Wide-field fundus photograph from neonatal ROP screening: 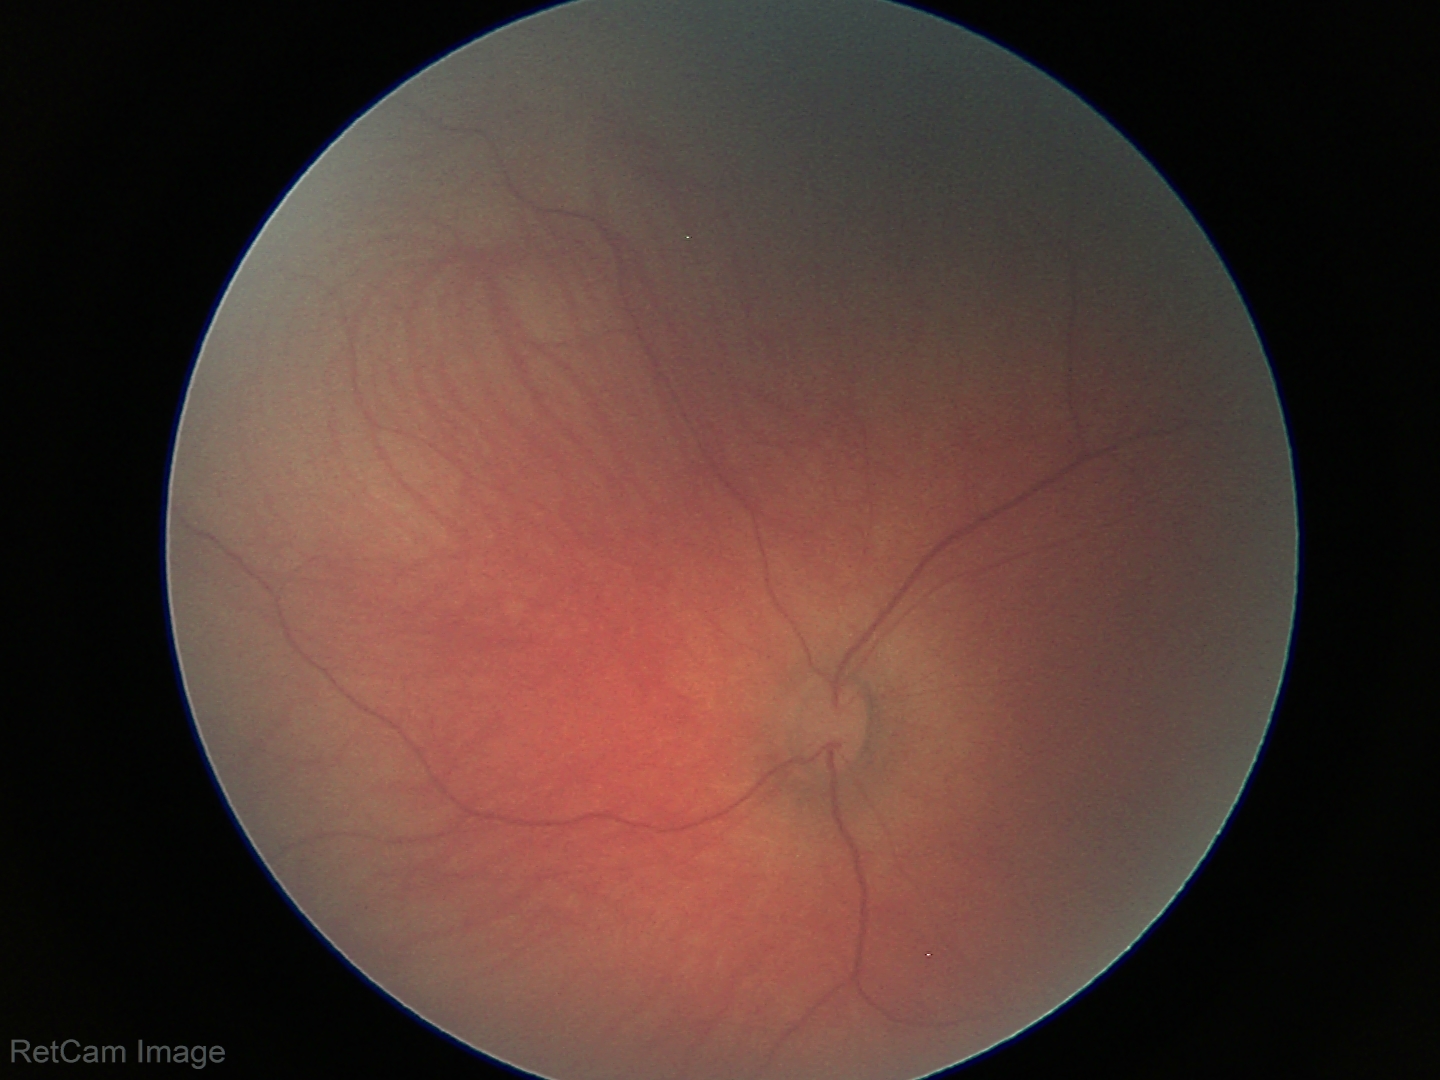

Normal screening examination.